848 by 848 pixels, without pupil dilation:
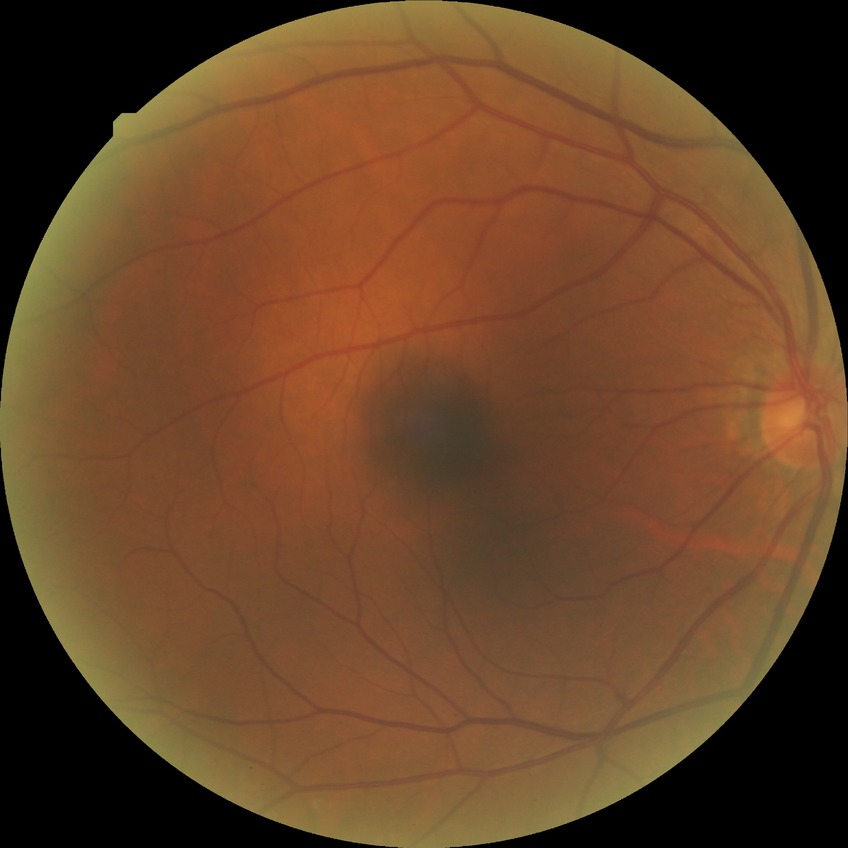
DR stage: NDR.